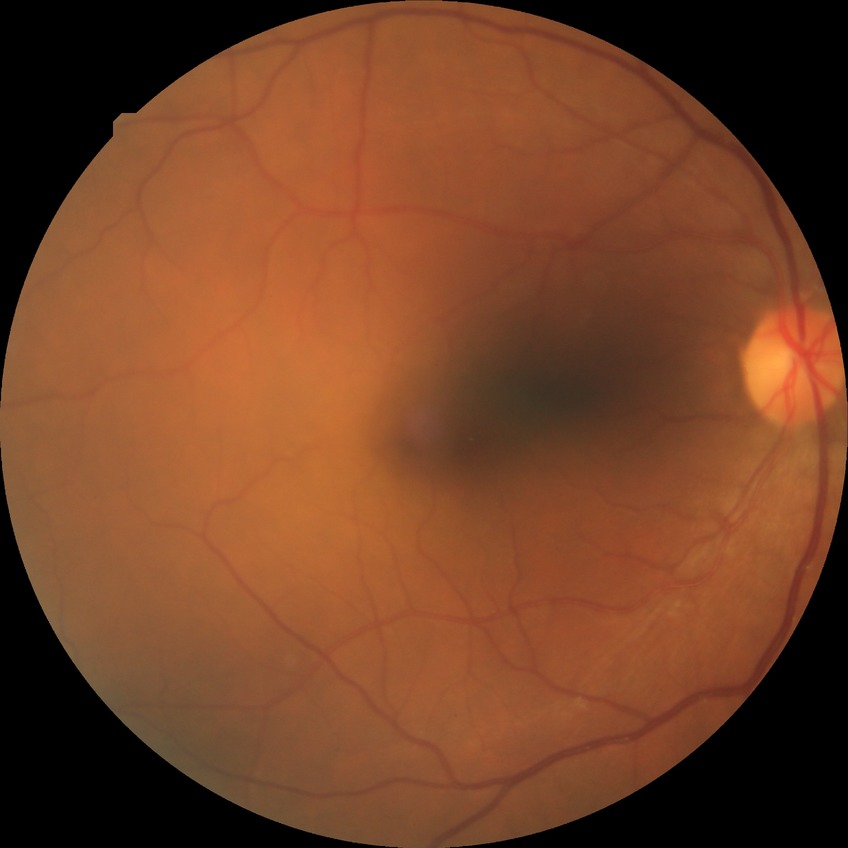

retinopathy stage: no diabetic retinopathy.